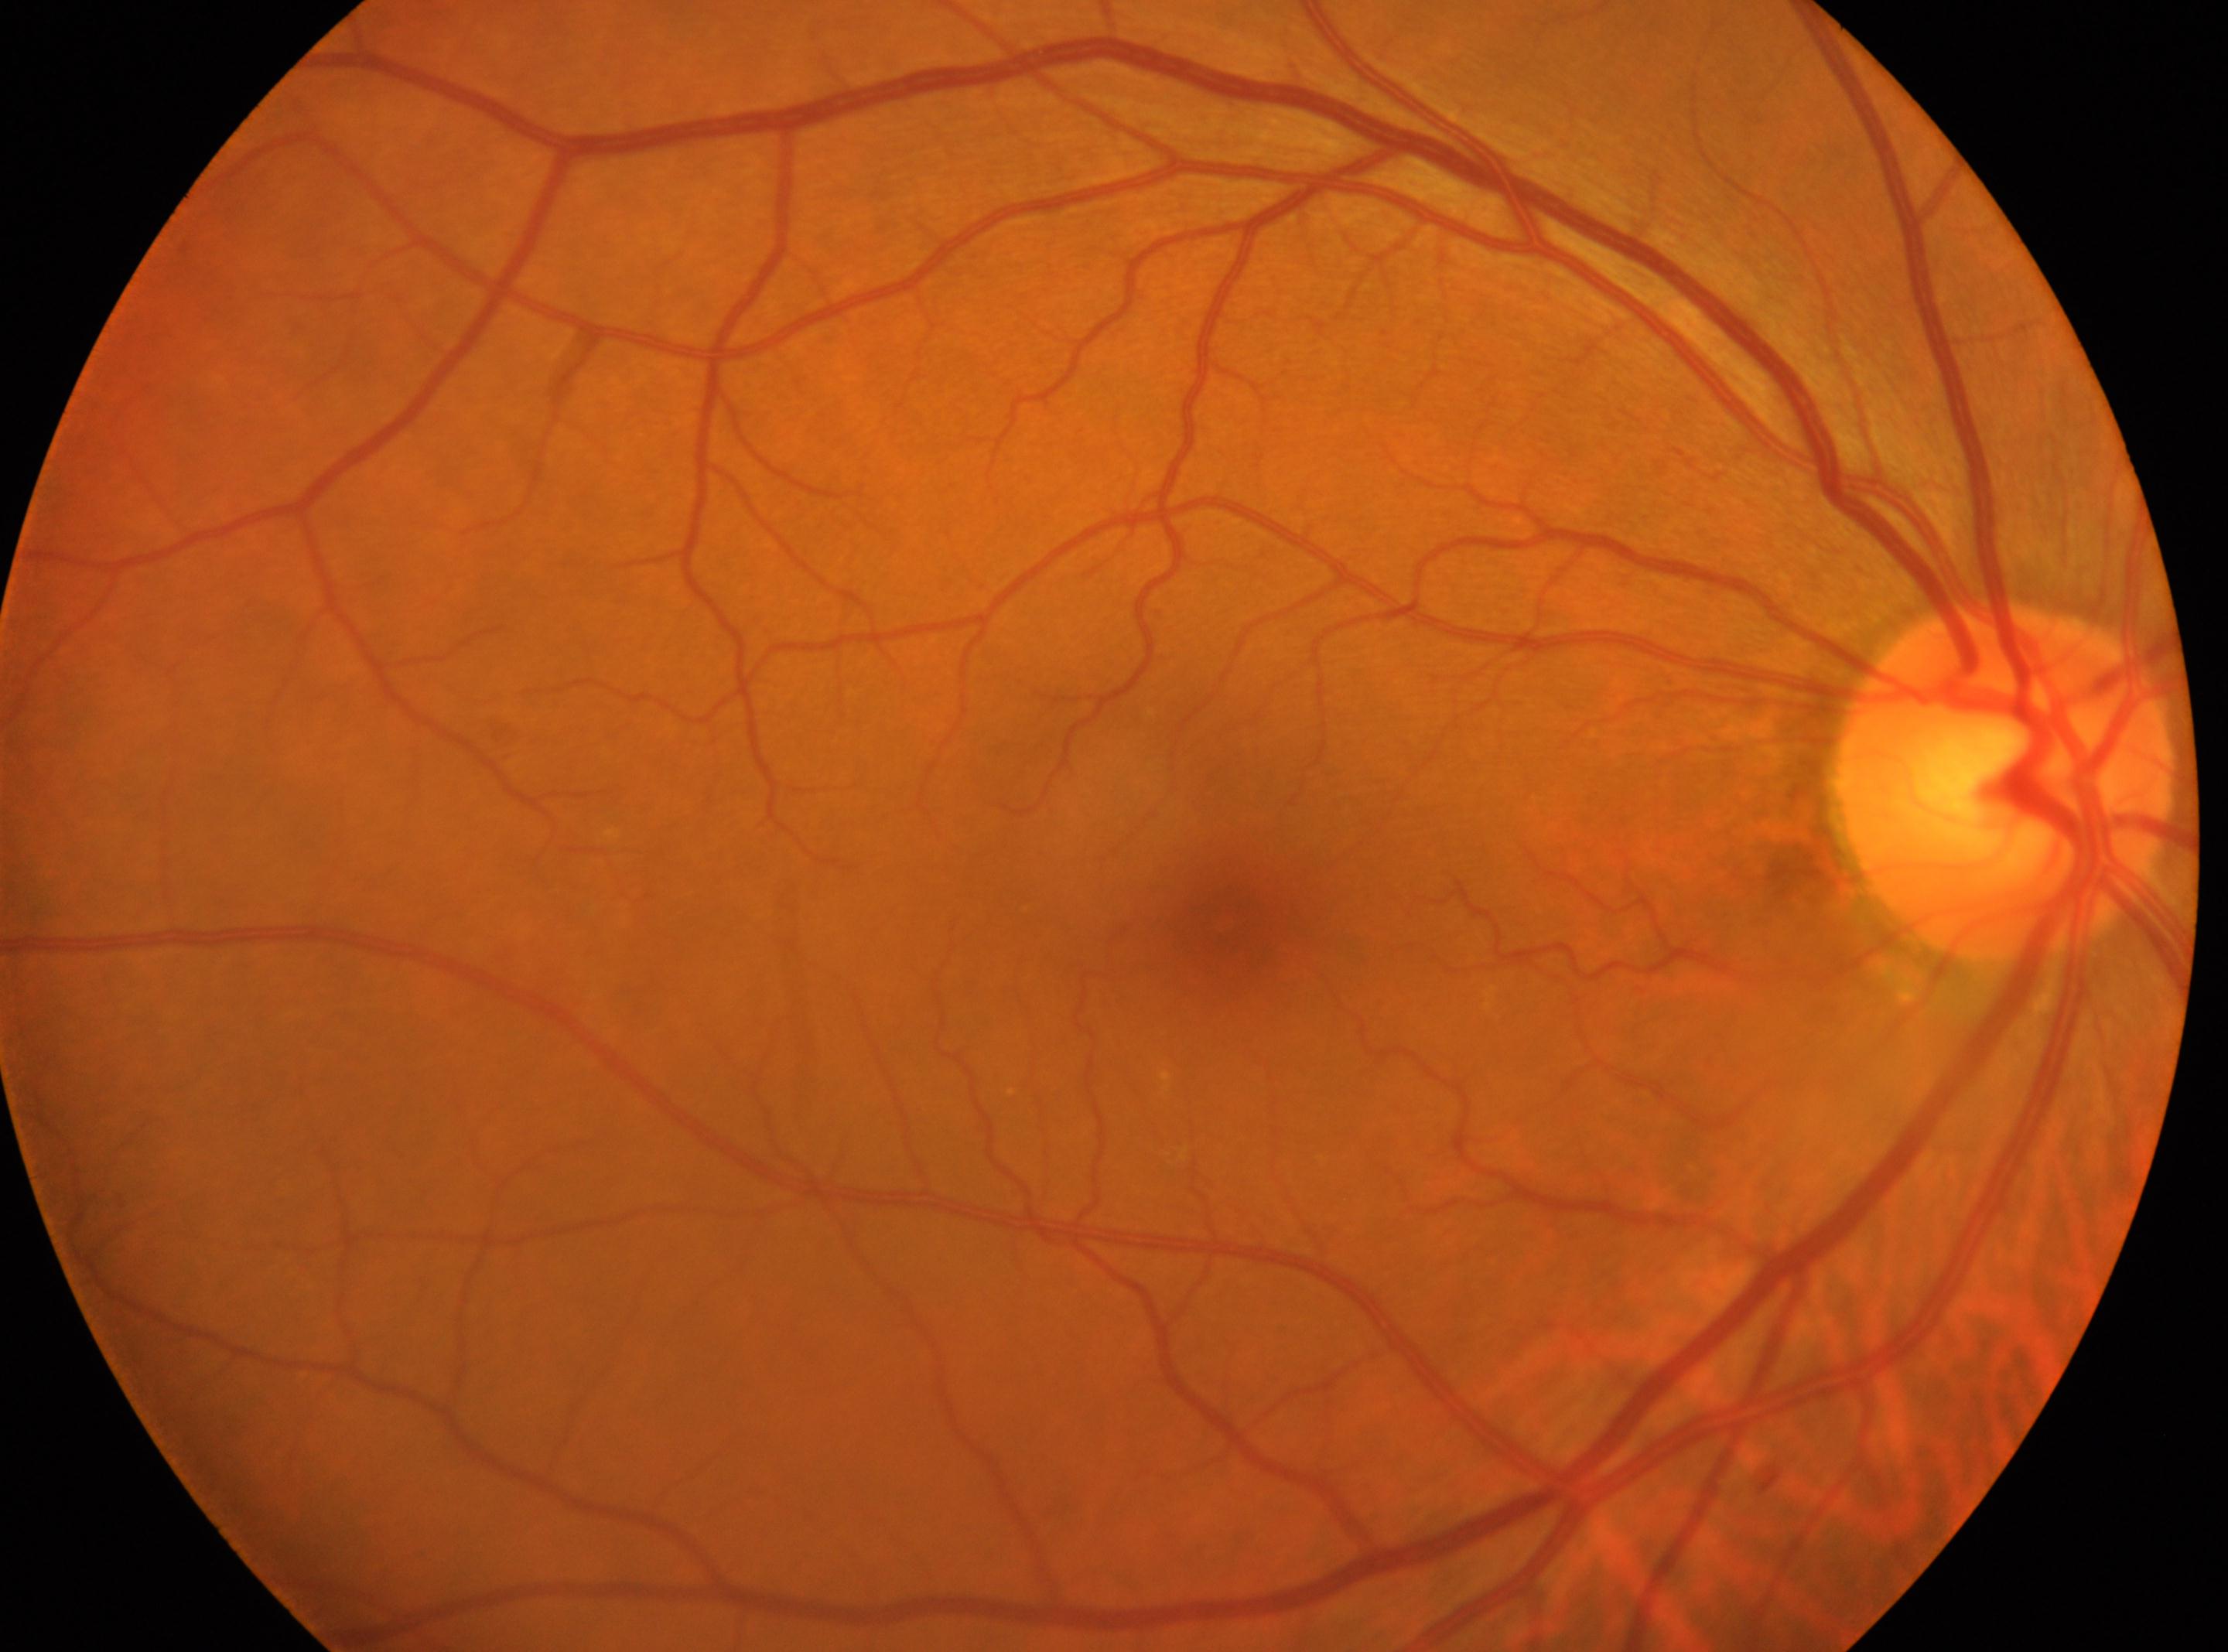 | key | value |
|---|---|
| DR impression | No signs of diabetic retinopathy |
| laterality | right |
| fovea center | (x: 1222, y: 920) |
| disc center | (x: 2003, y: 783) |
| DR | no apparent retinopathy (grade 0) |